Handheld portable fundus camera image. 2212x1659px: 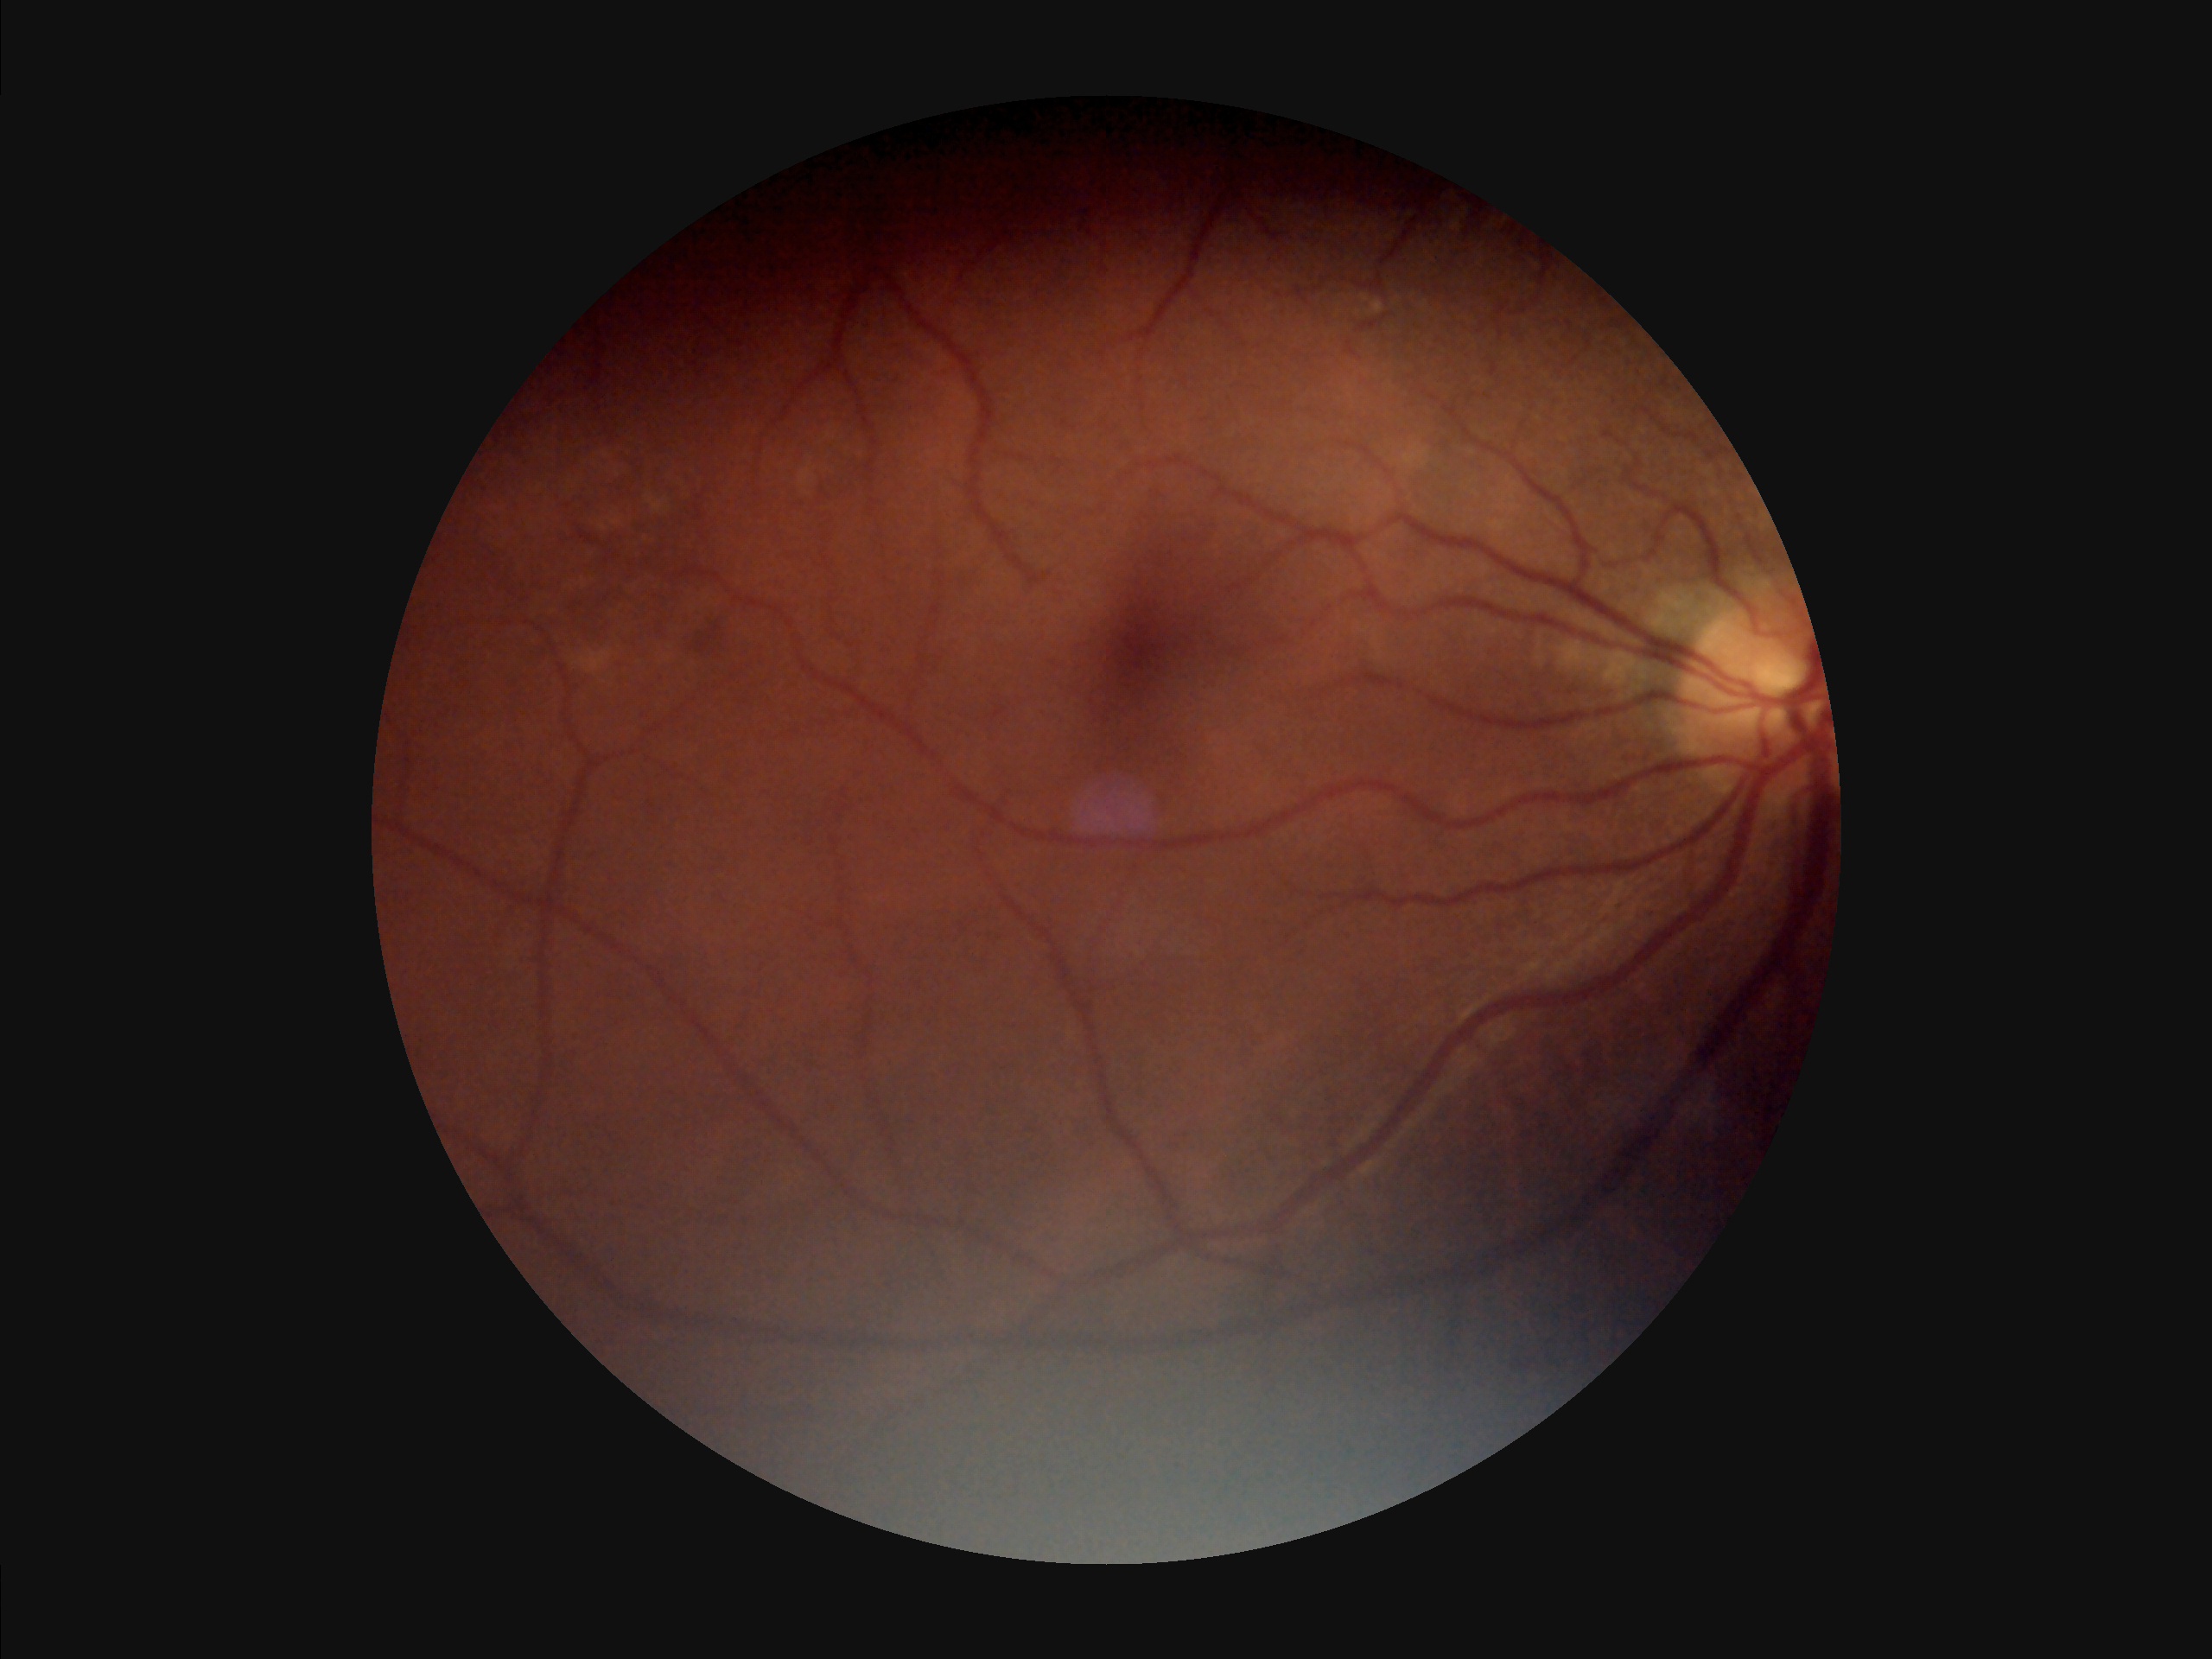

Sharpness = reduced | Contrast = reduced | Illumination/color = poor | Overall quality = suboptimal.